CFP.
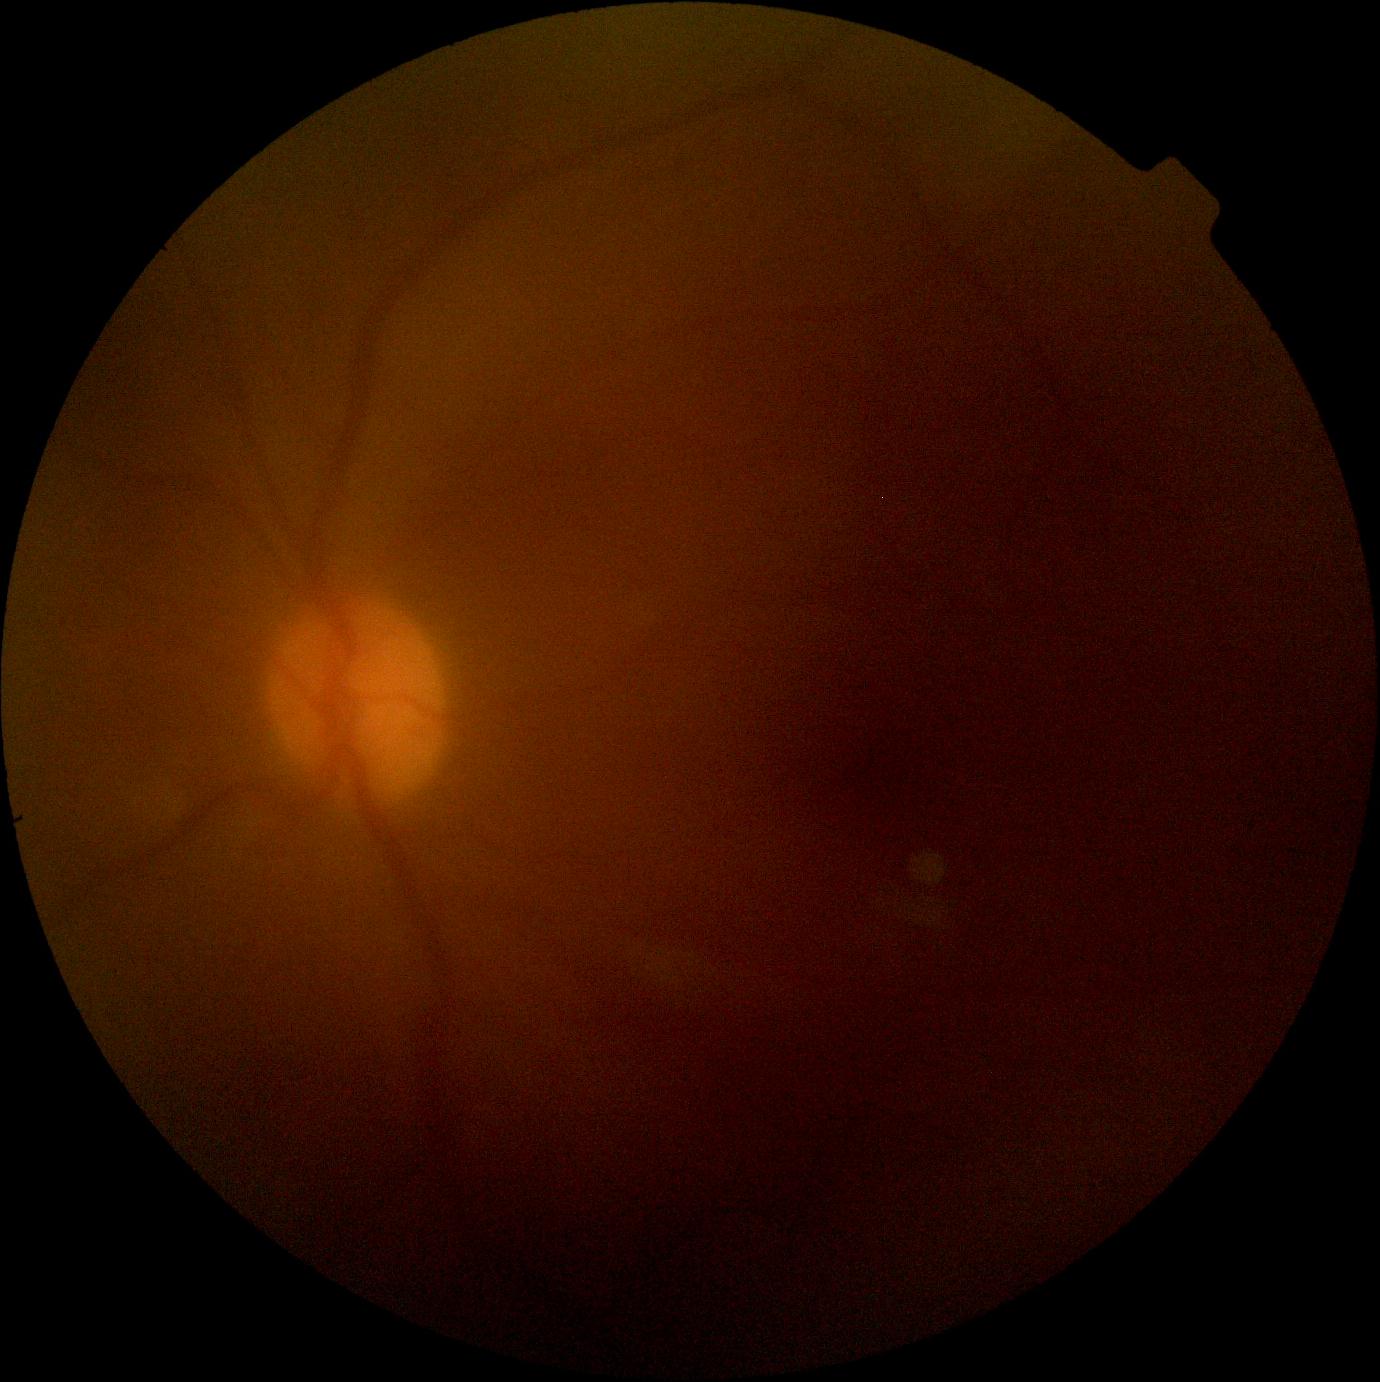
Quality too poor to assess for DR. DR is ungradable due to poor image quality.